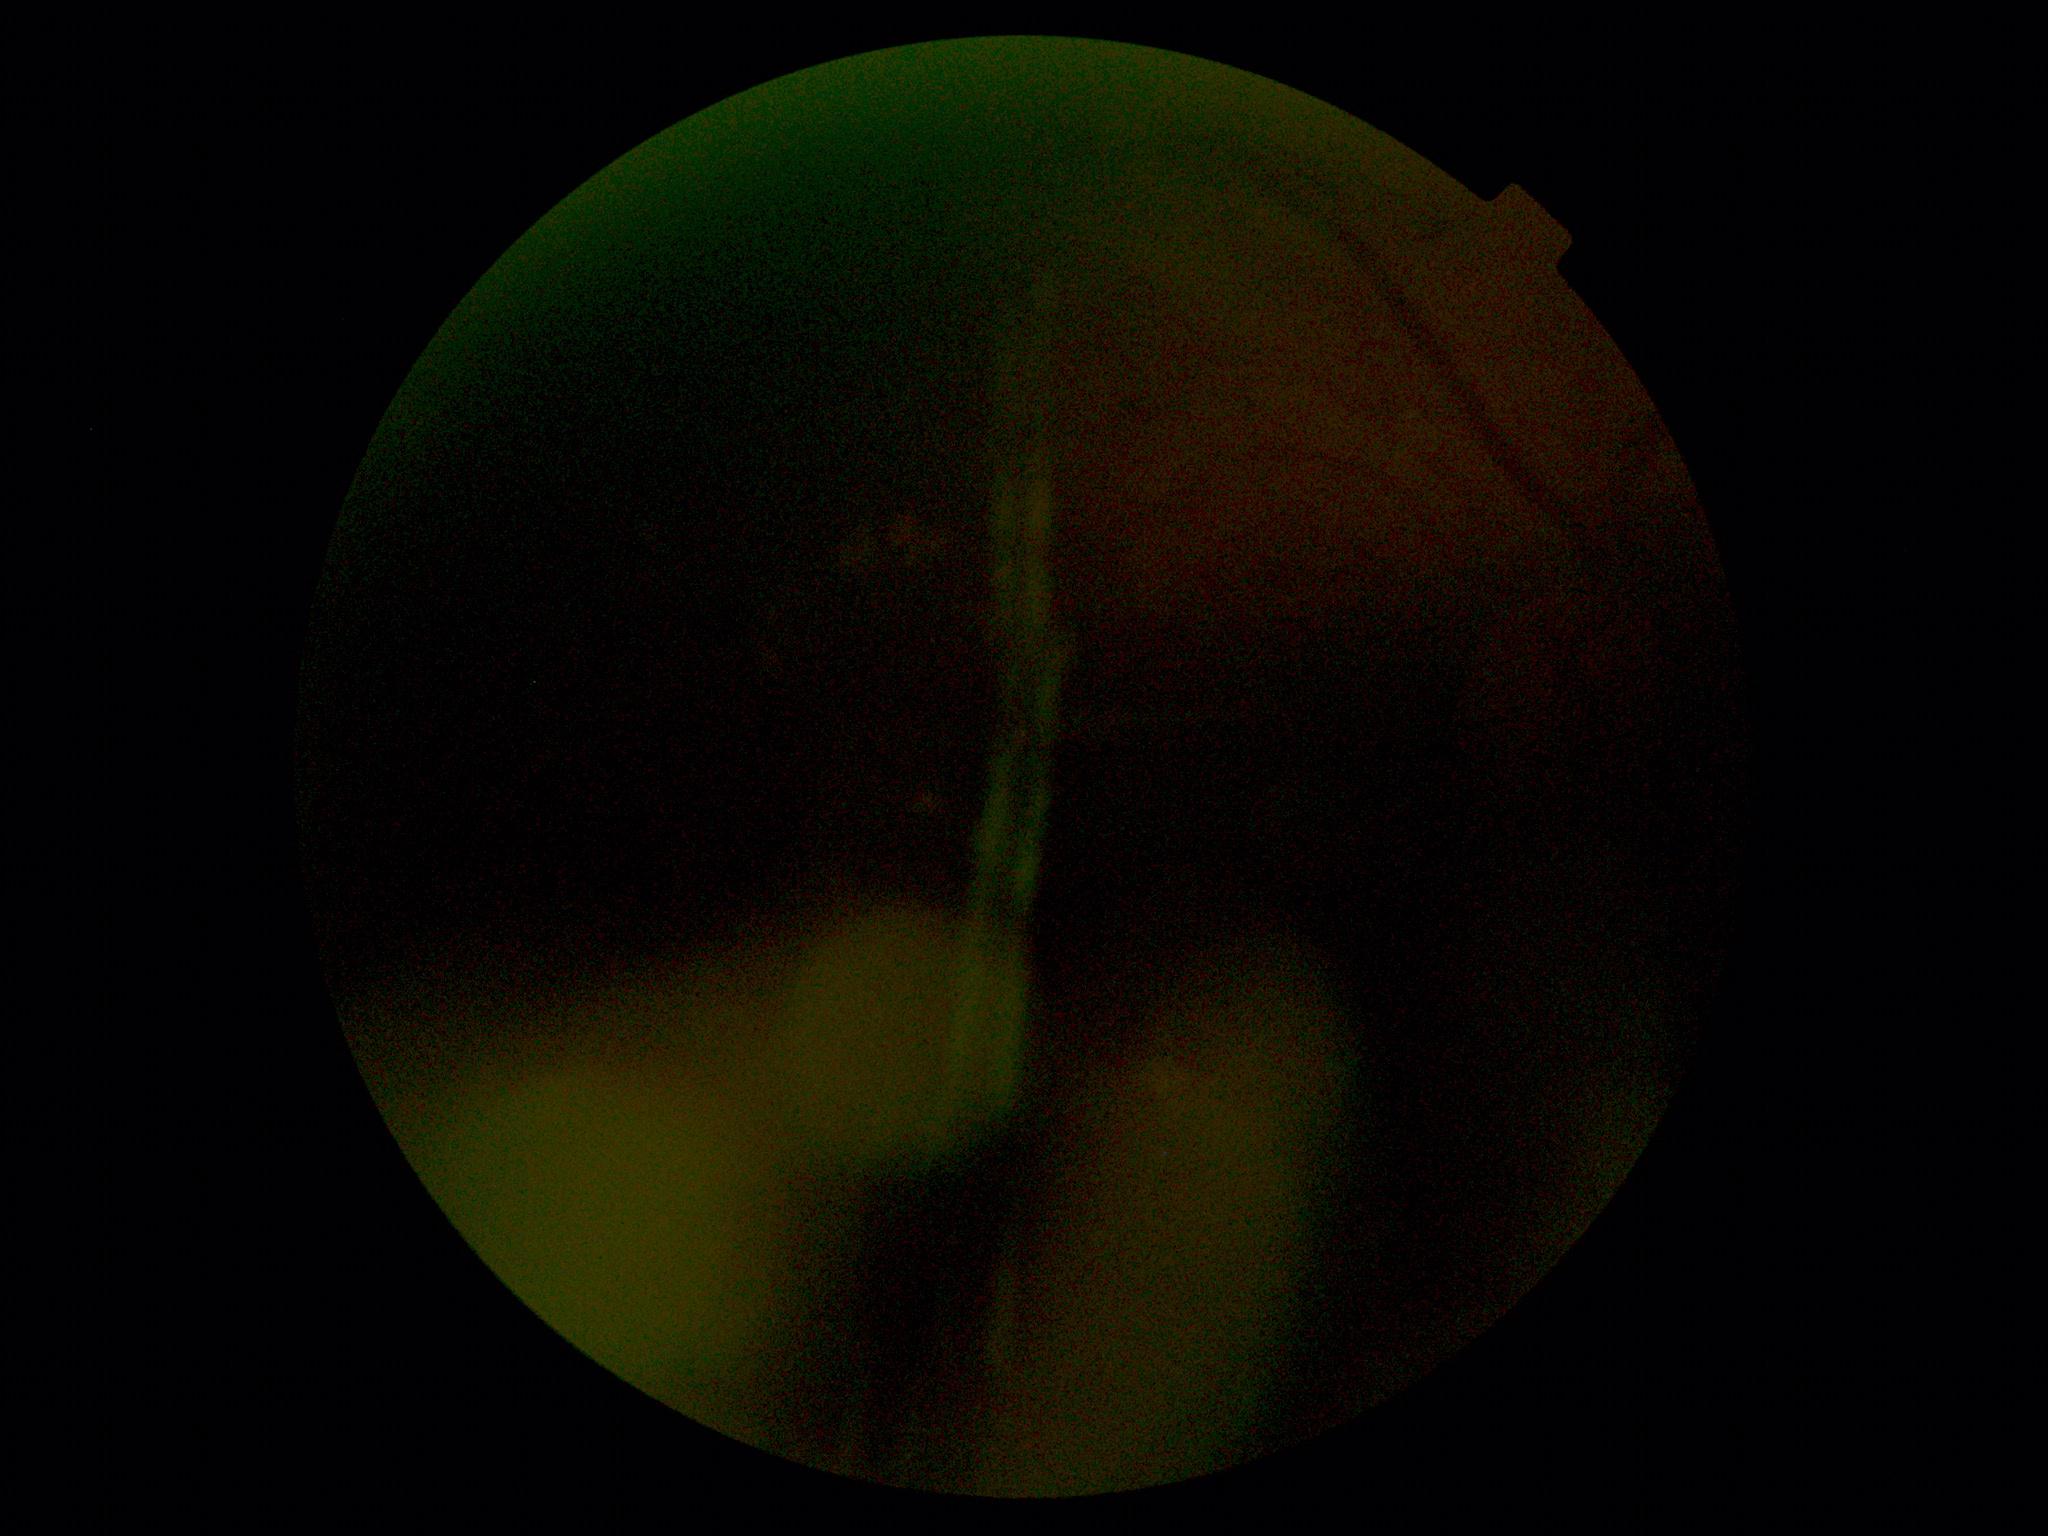 Annotations:
• diabetic retinopathy — ungradable
• image quality — too poor for DR grading